Image size 640x480. Wide-field fundus photograph from neonatal ROP screening. Captured with the Clarity RetCam 3 (130° field of view) — 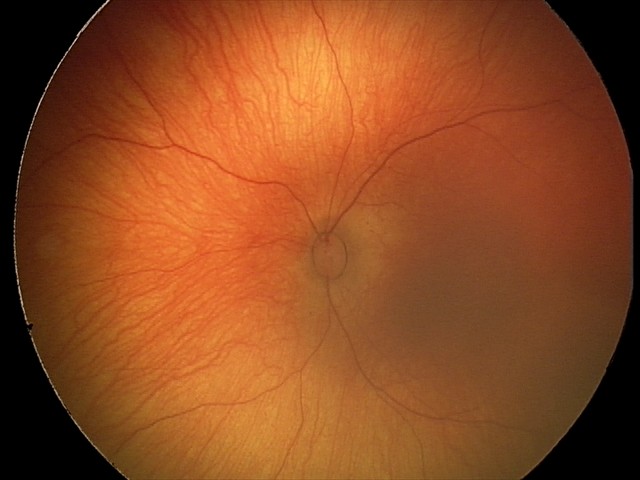

Q: What is the diagnosis from this examination?
A: physiological appearance with no retinal pathology